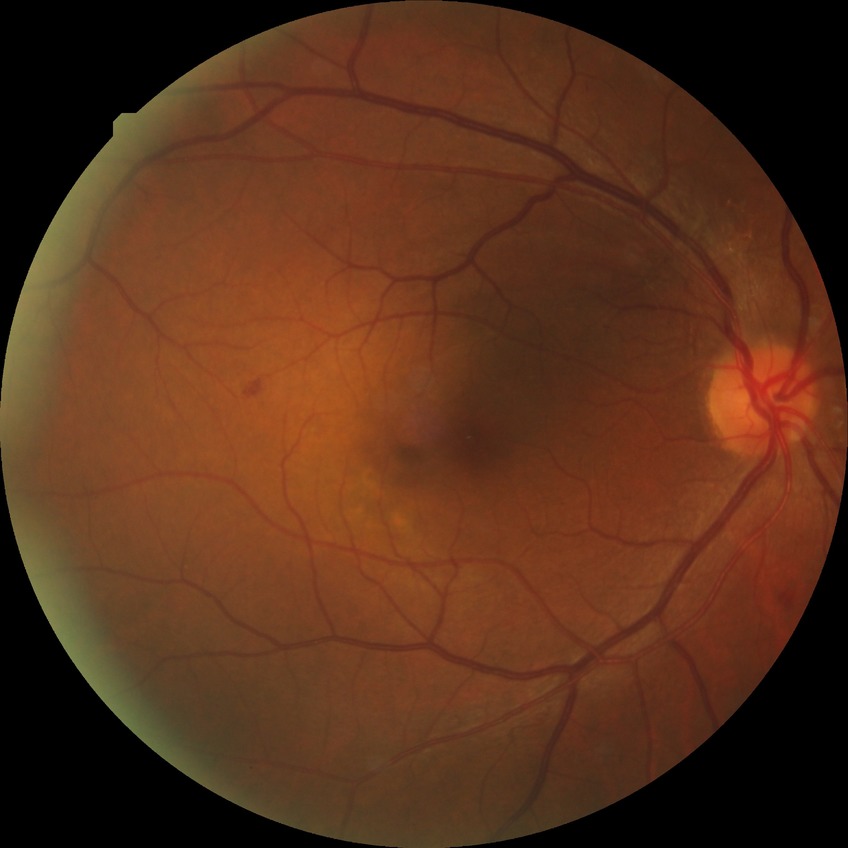 diabetic retinopathy (DR) = simple diabetic retinopathy (SDR).